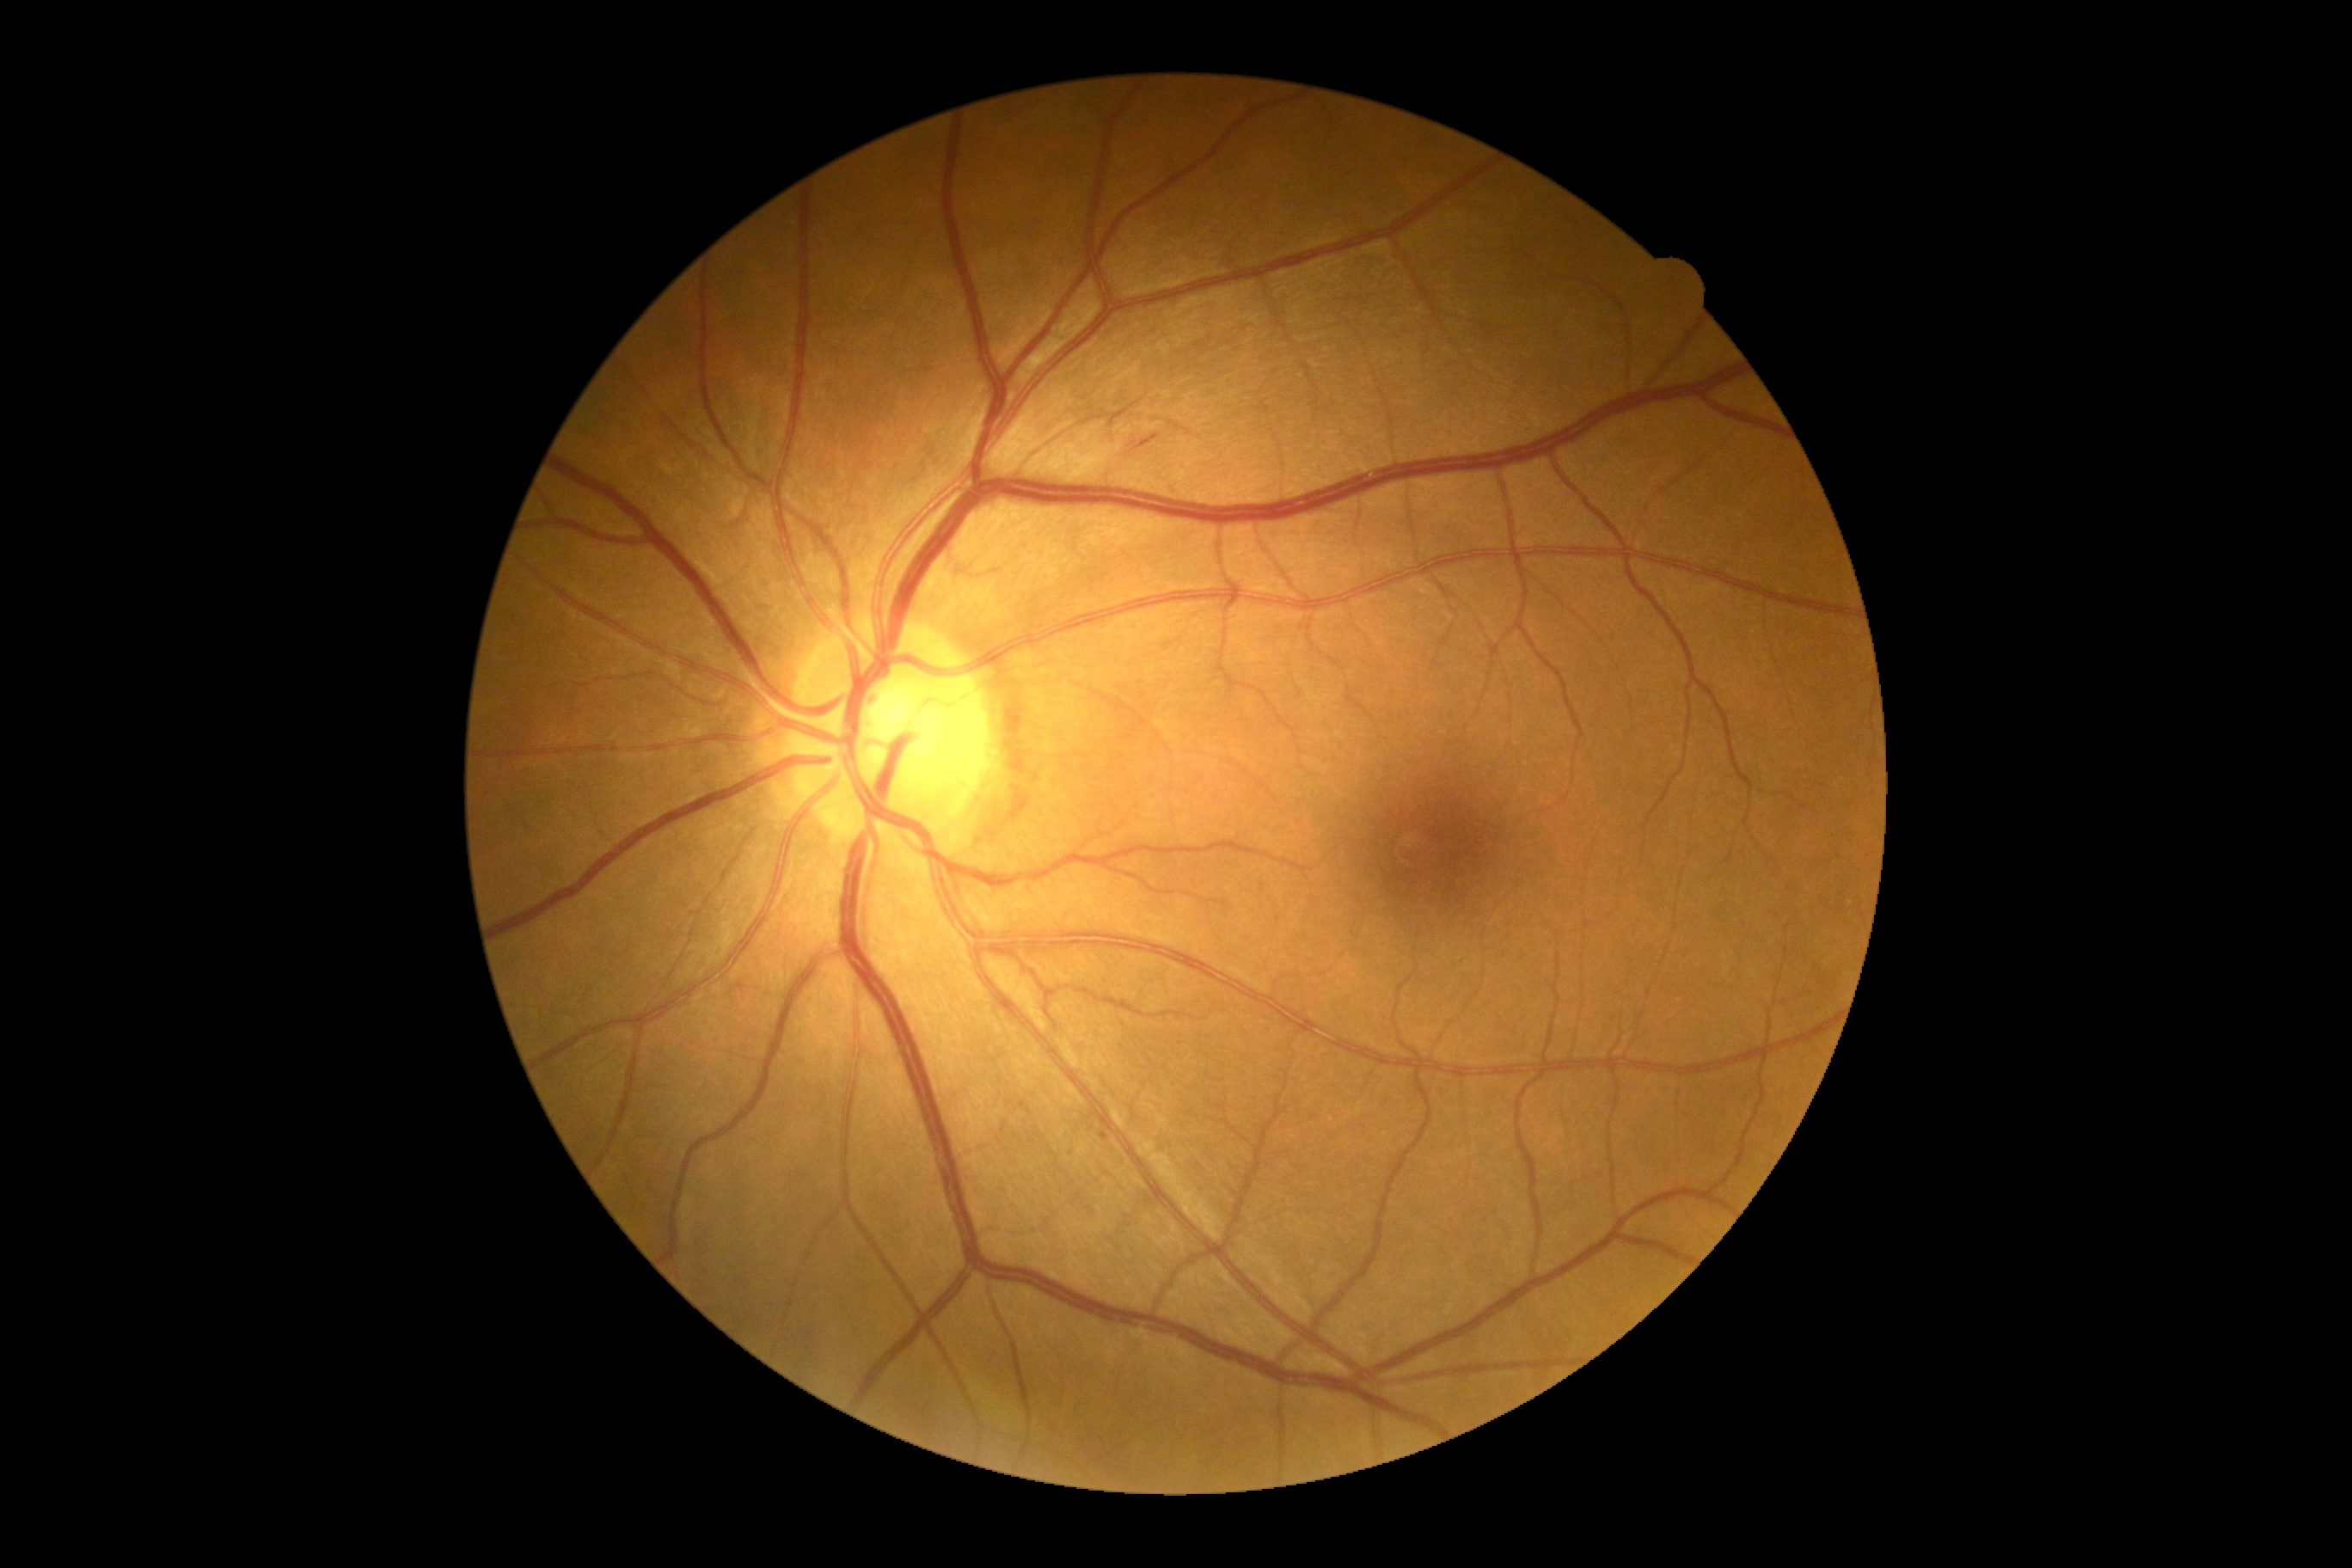

DR class@non-proliferative diabetic retinopathy, diabetic retinopathy severity@moderate non-proliferative diabetic retinopathy (grade 2).